Retinal fundus photograph · 2352 by 1568 pixels: 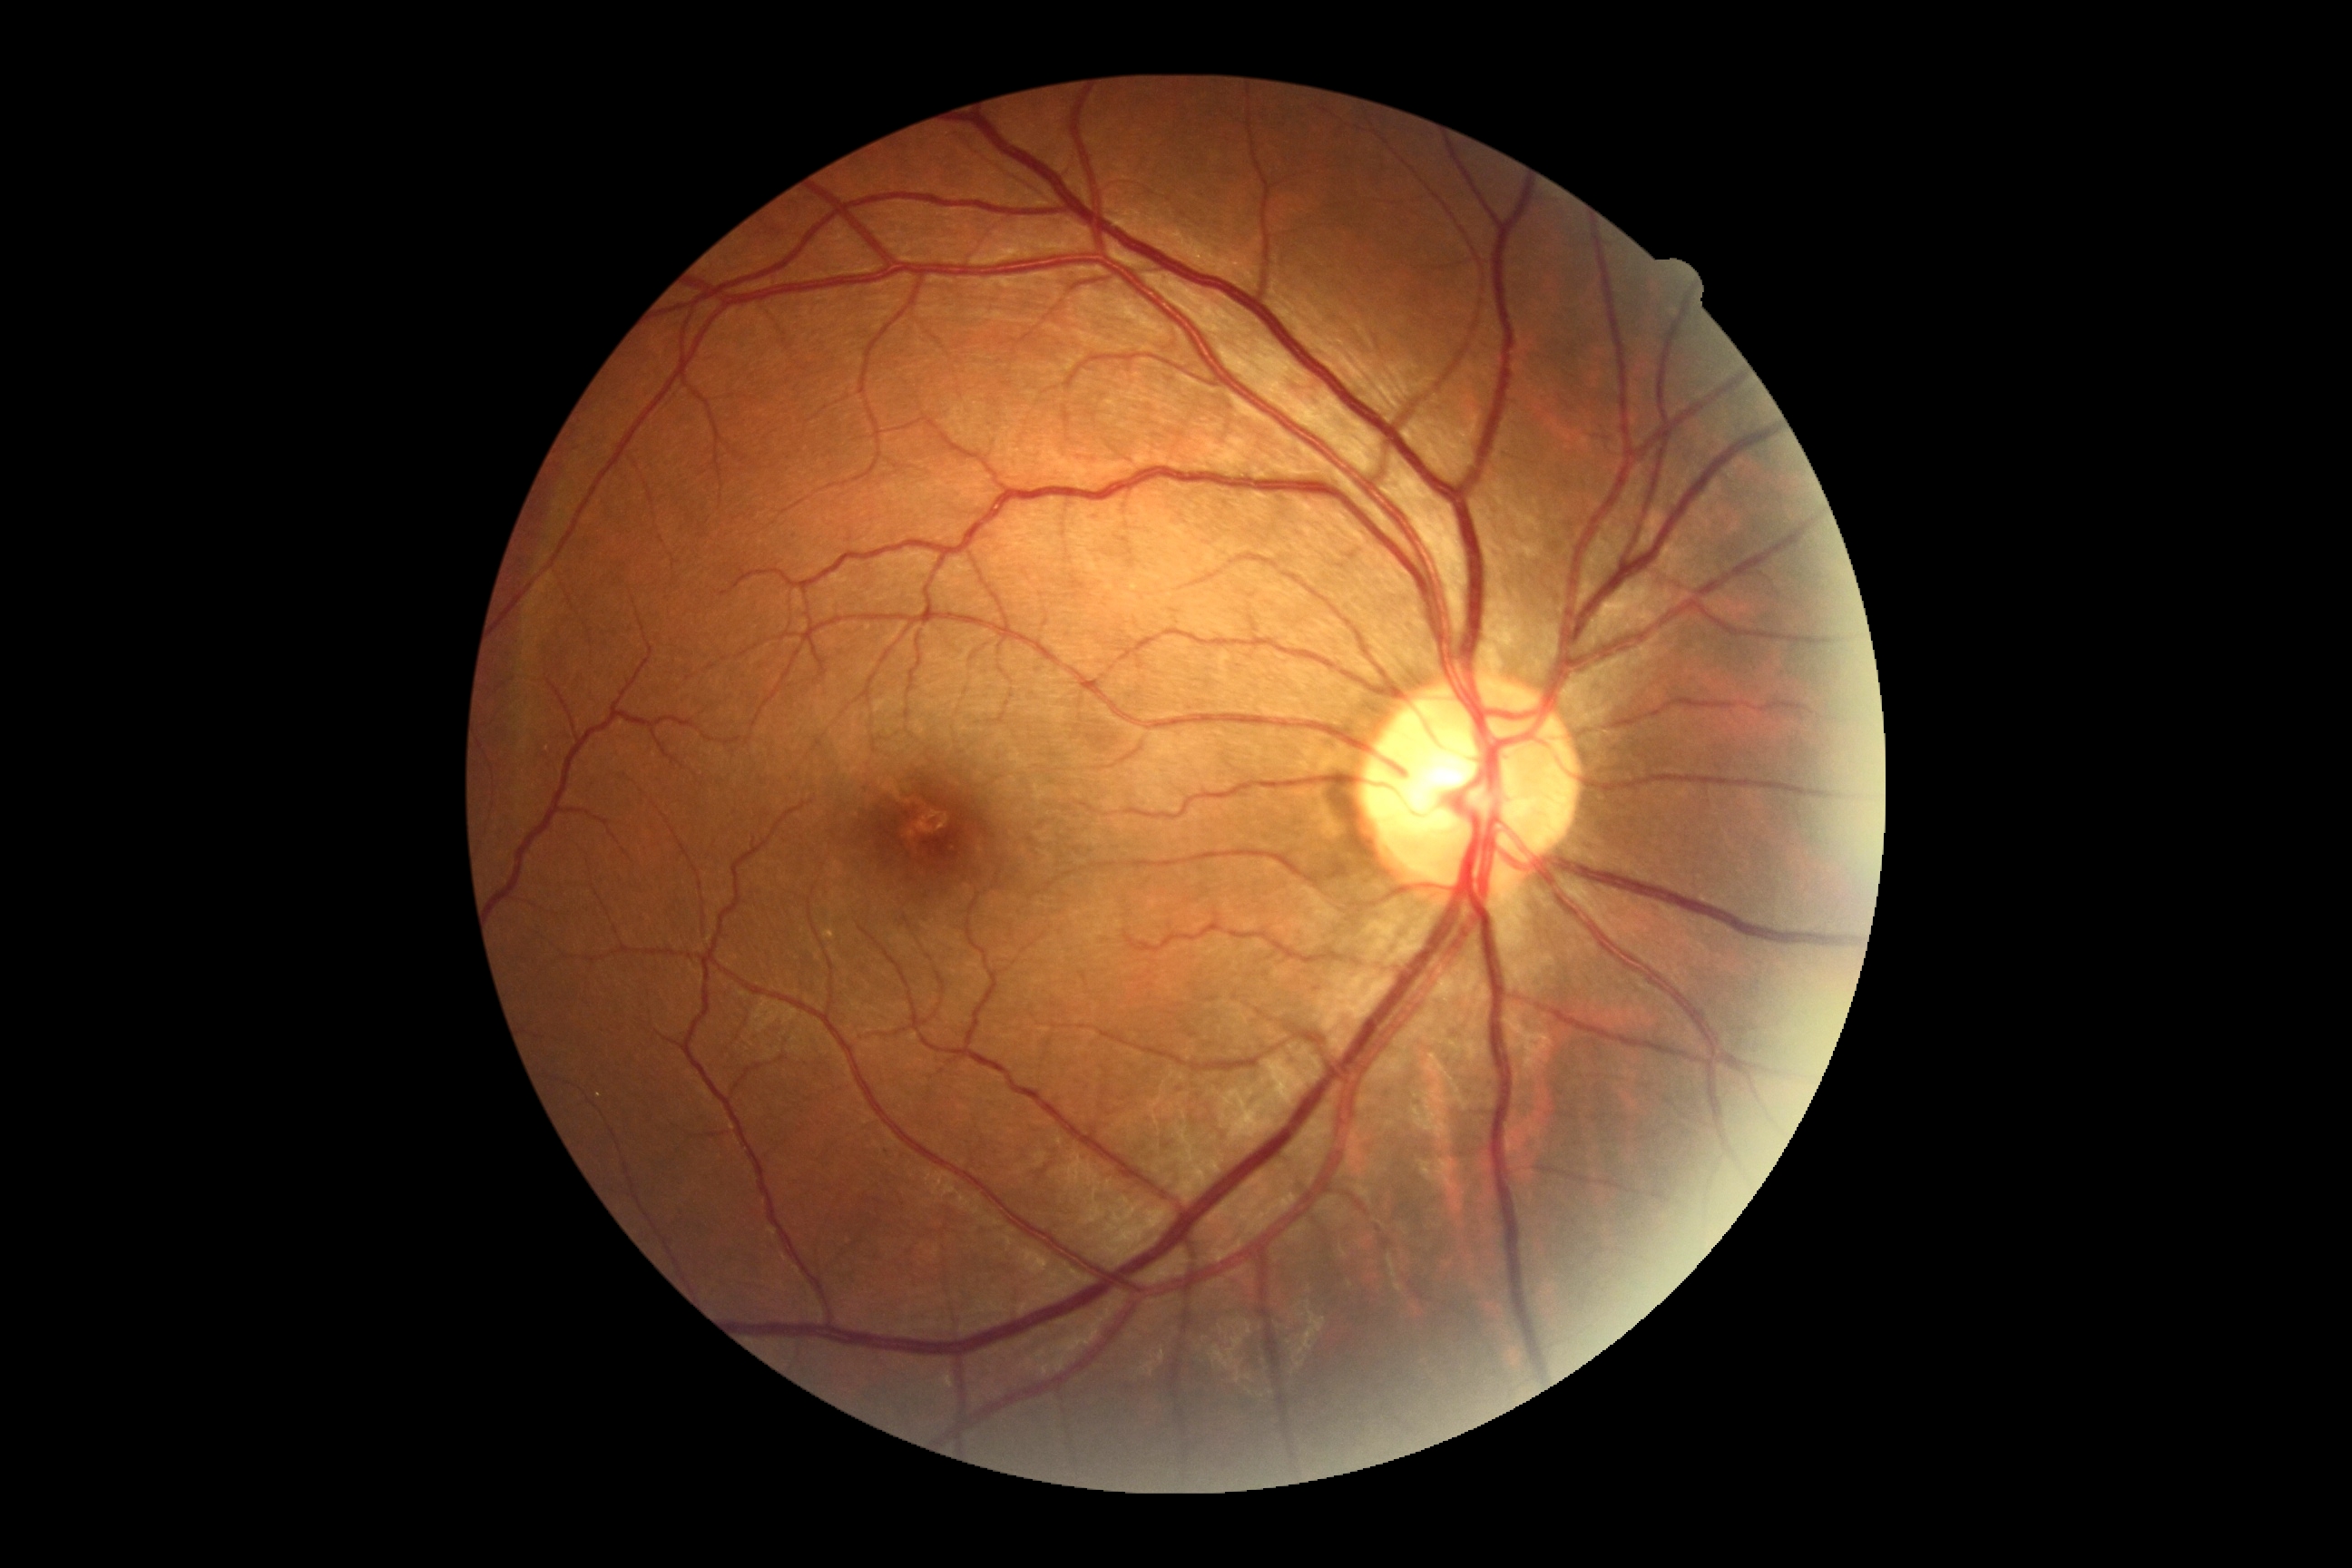
Retinopathy: 0.